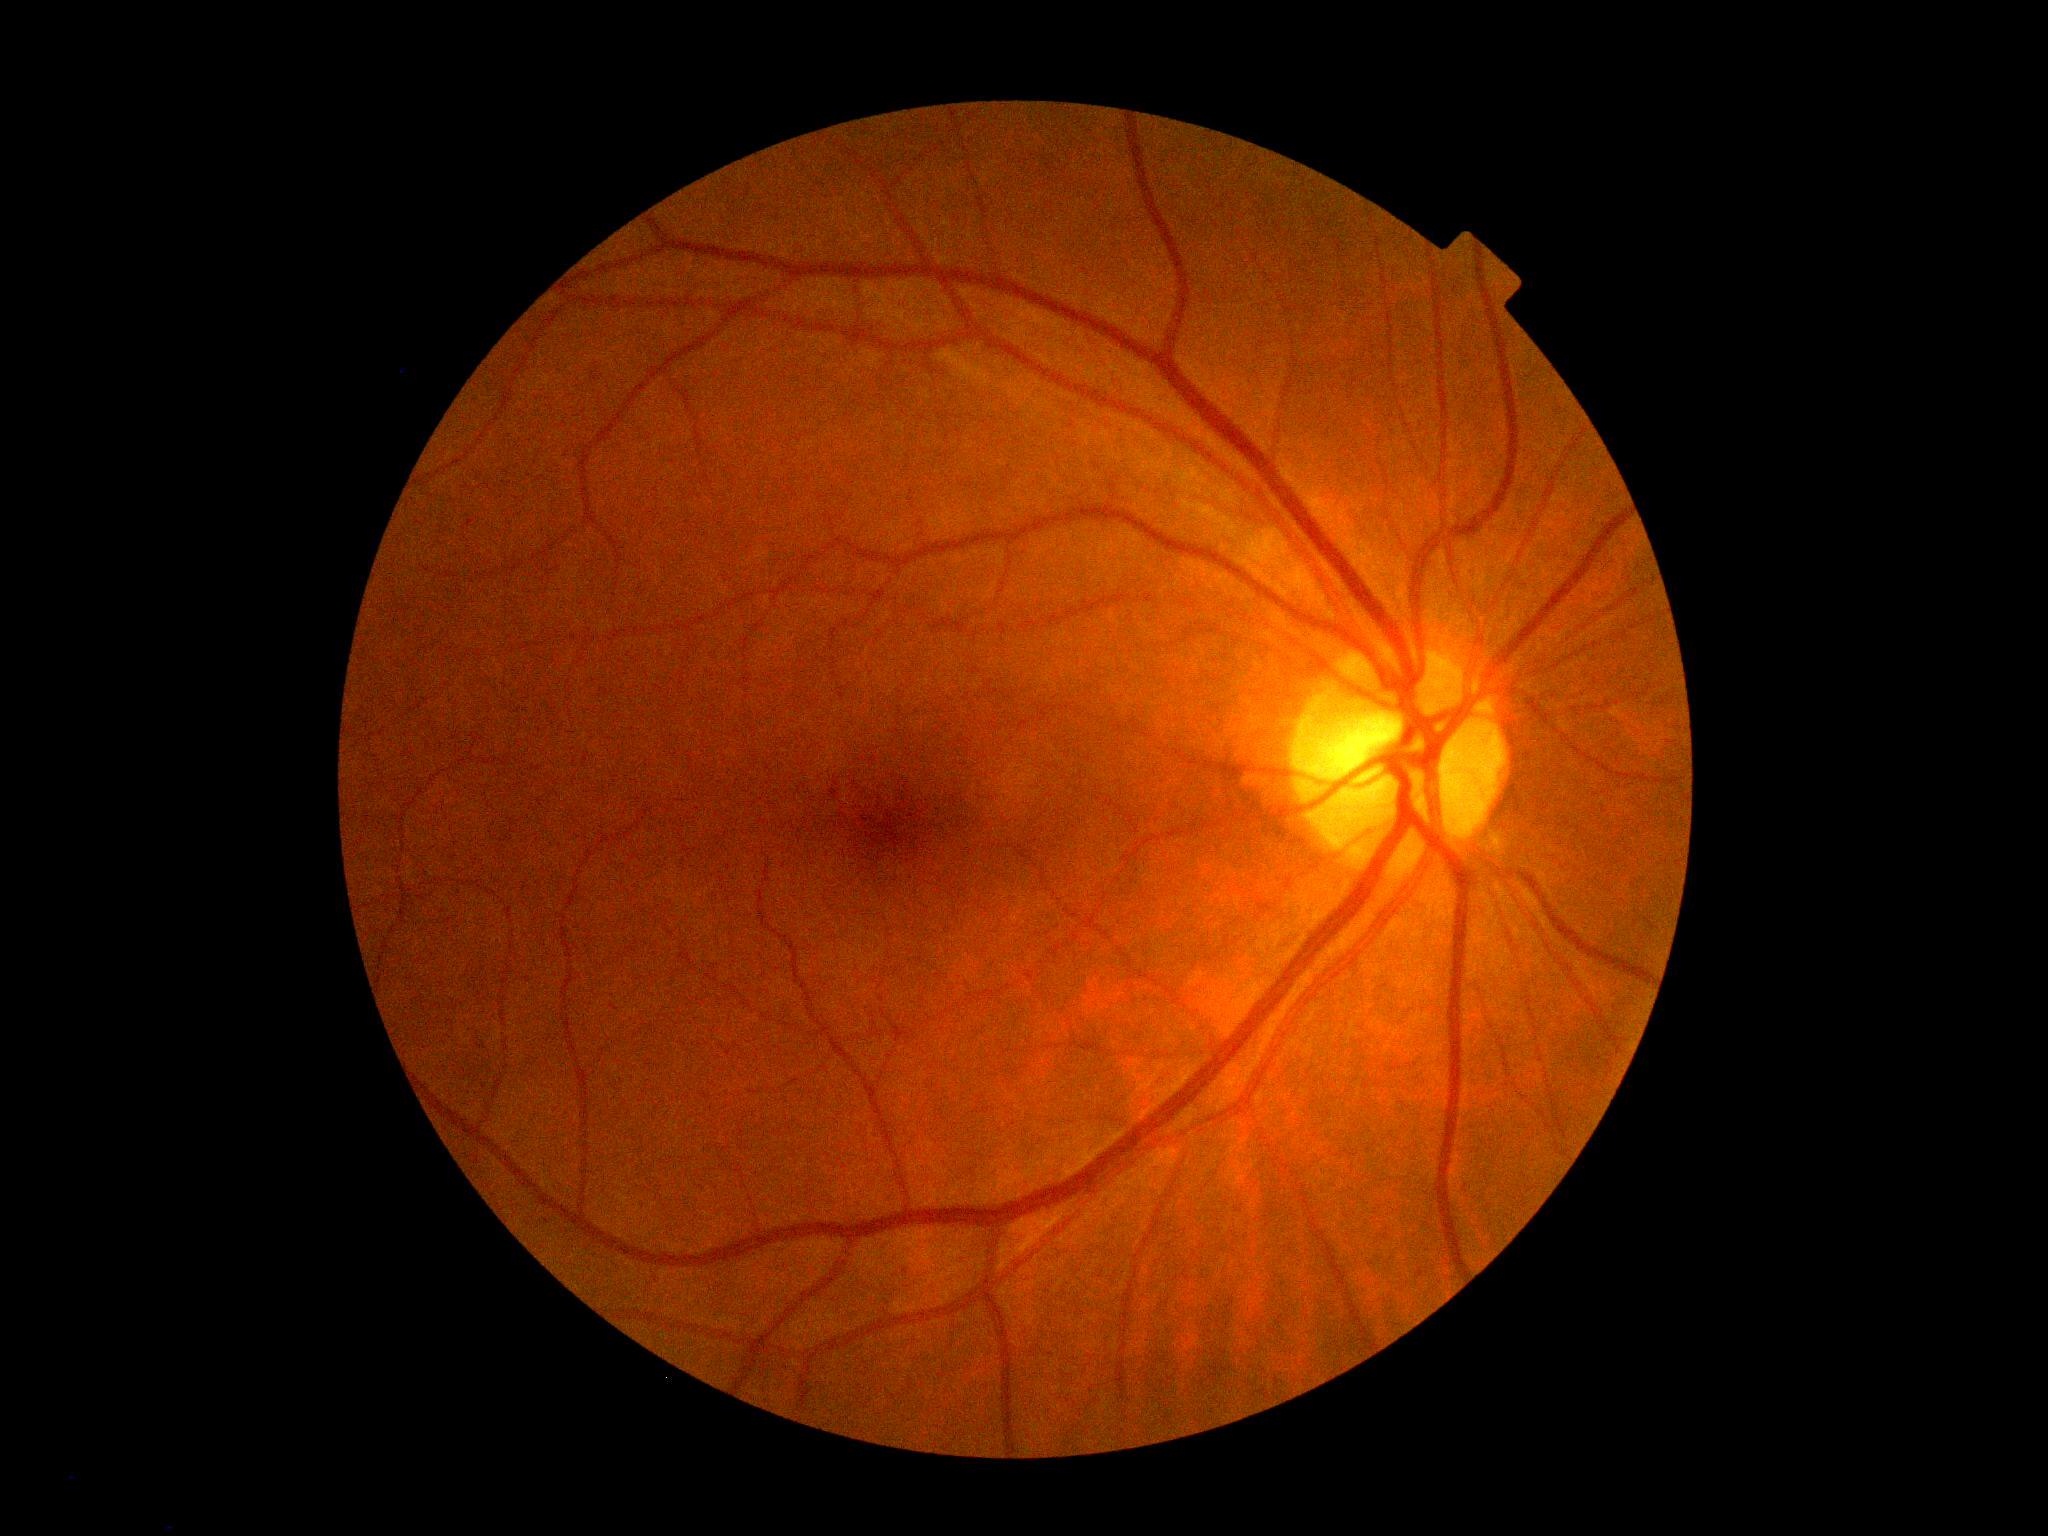 * DR stage — grade 0